Image size 2089x1764 · retinal fundus photograph:
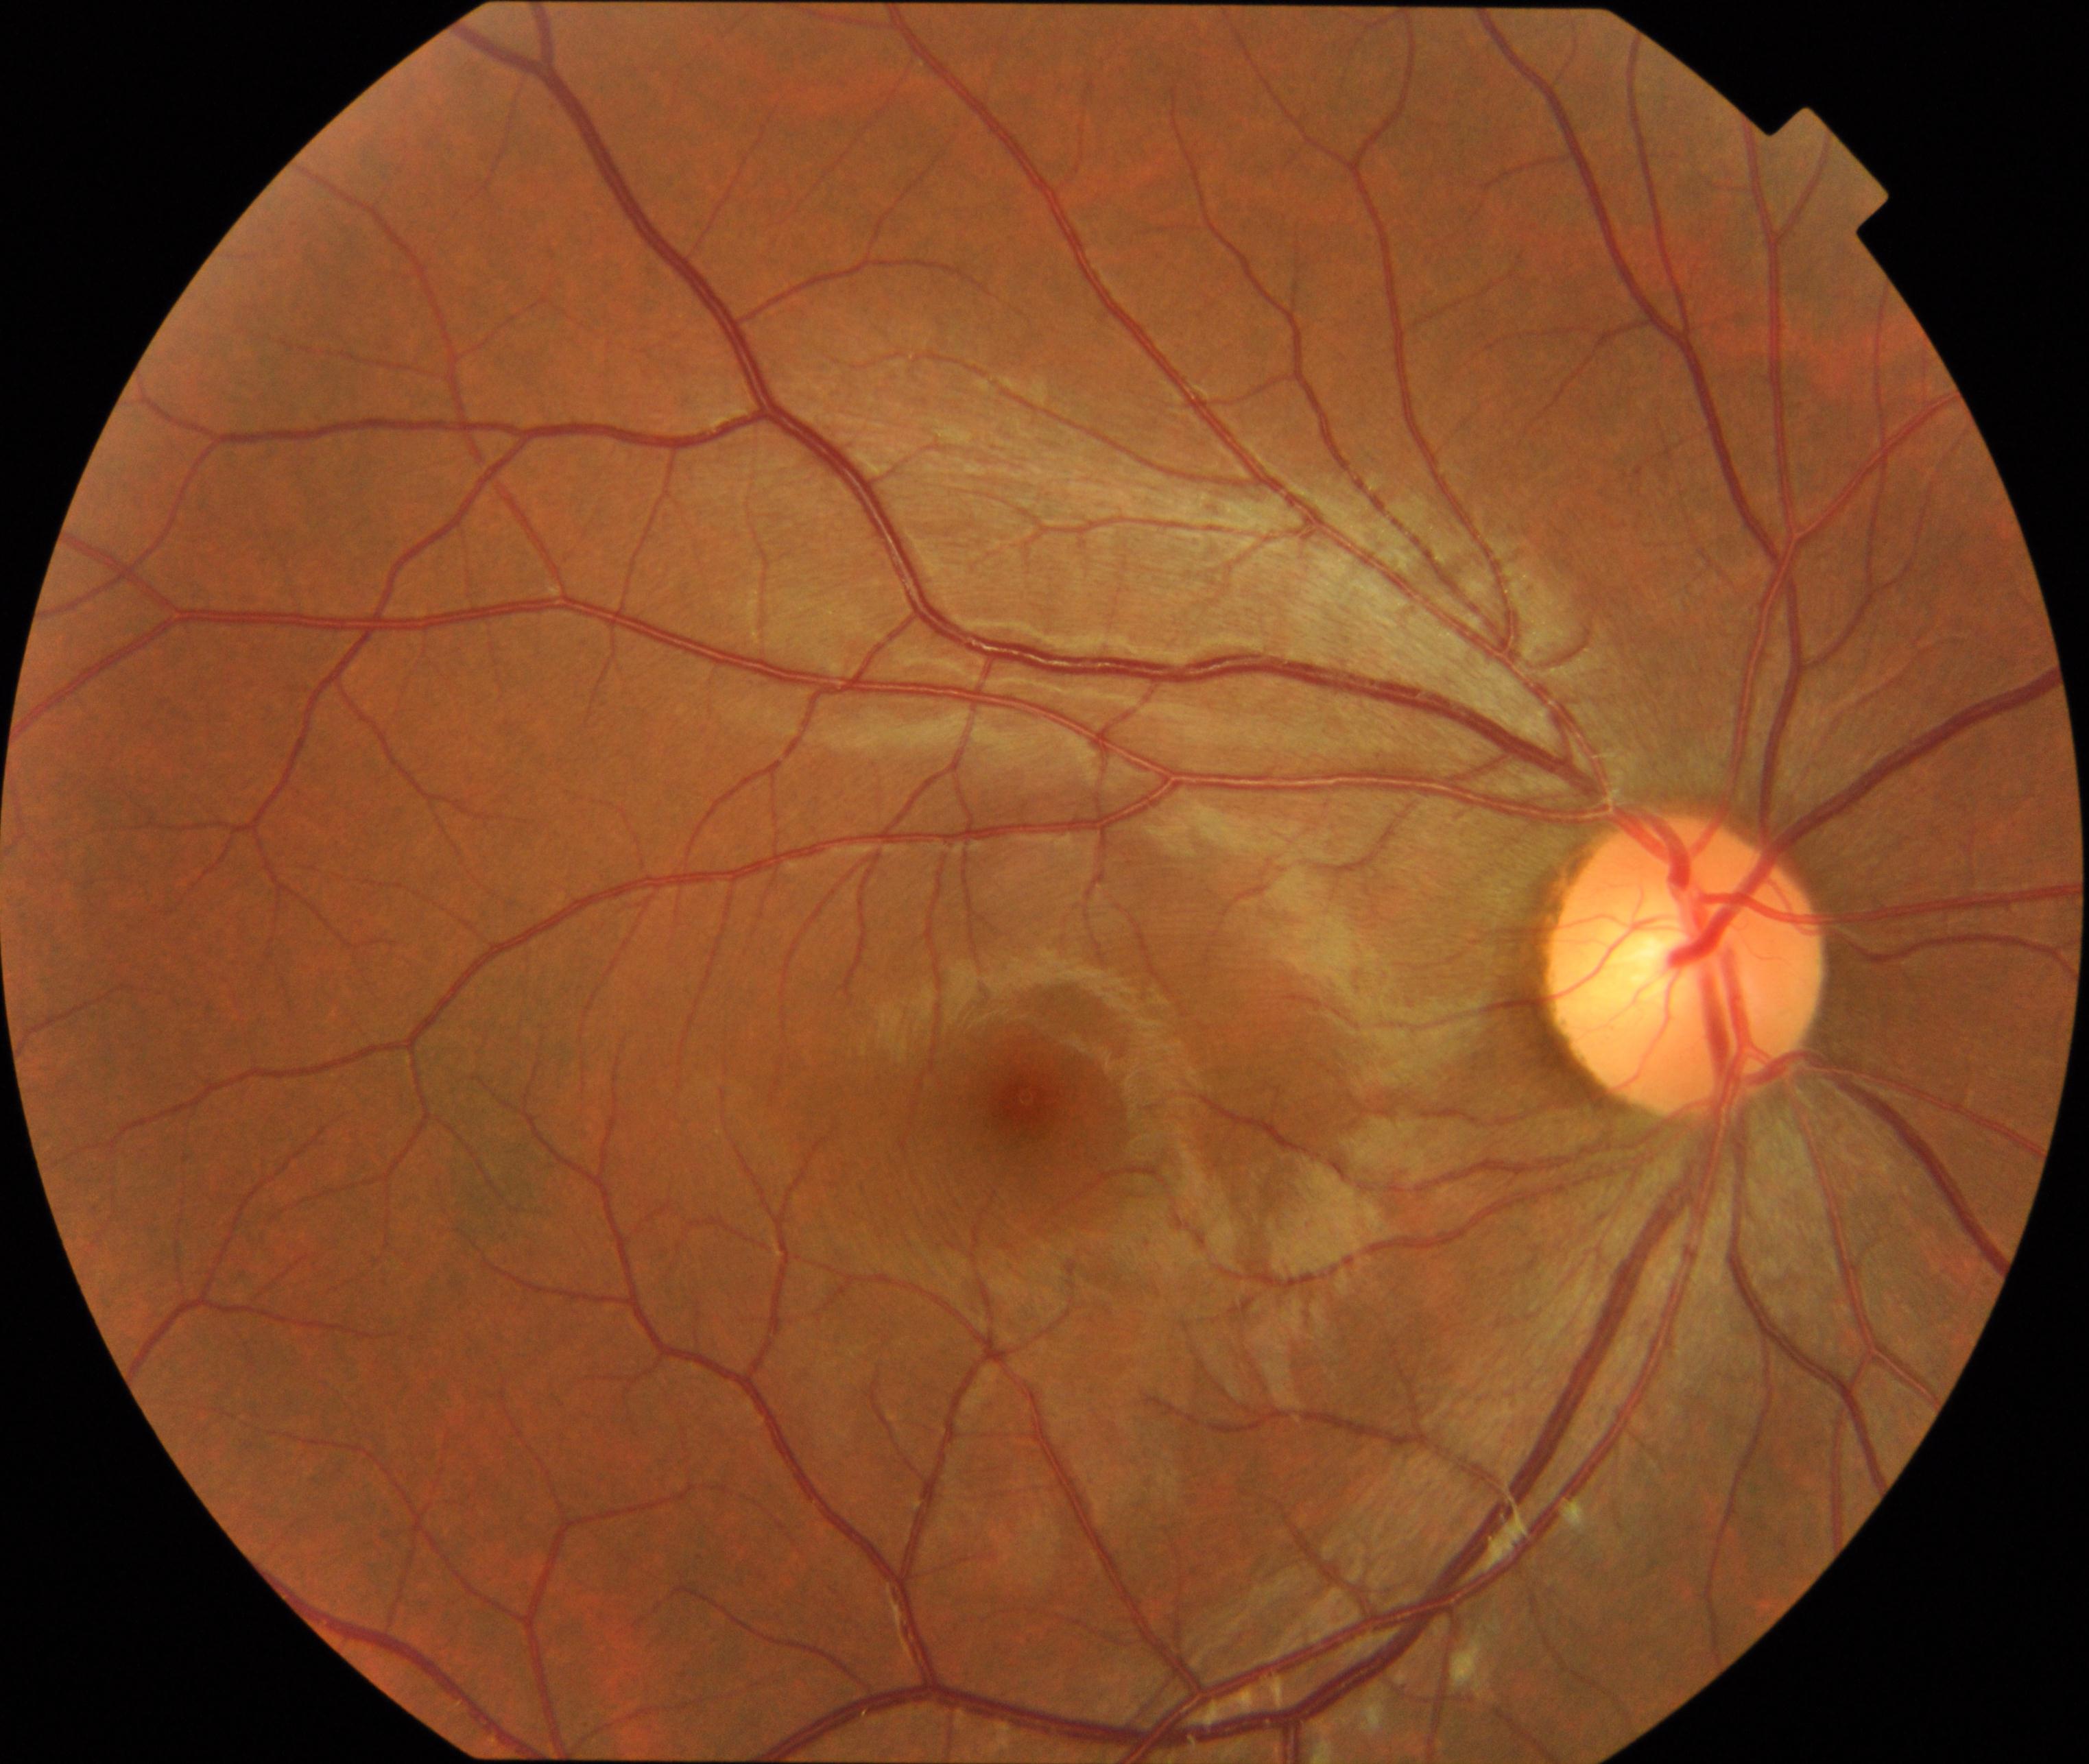
Normal fundus. No pathology identified.